45° field of view.
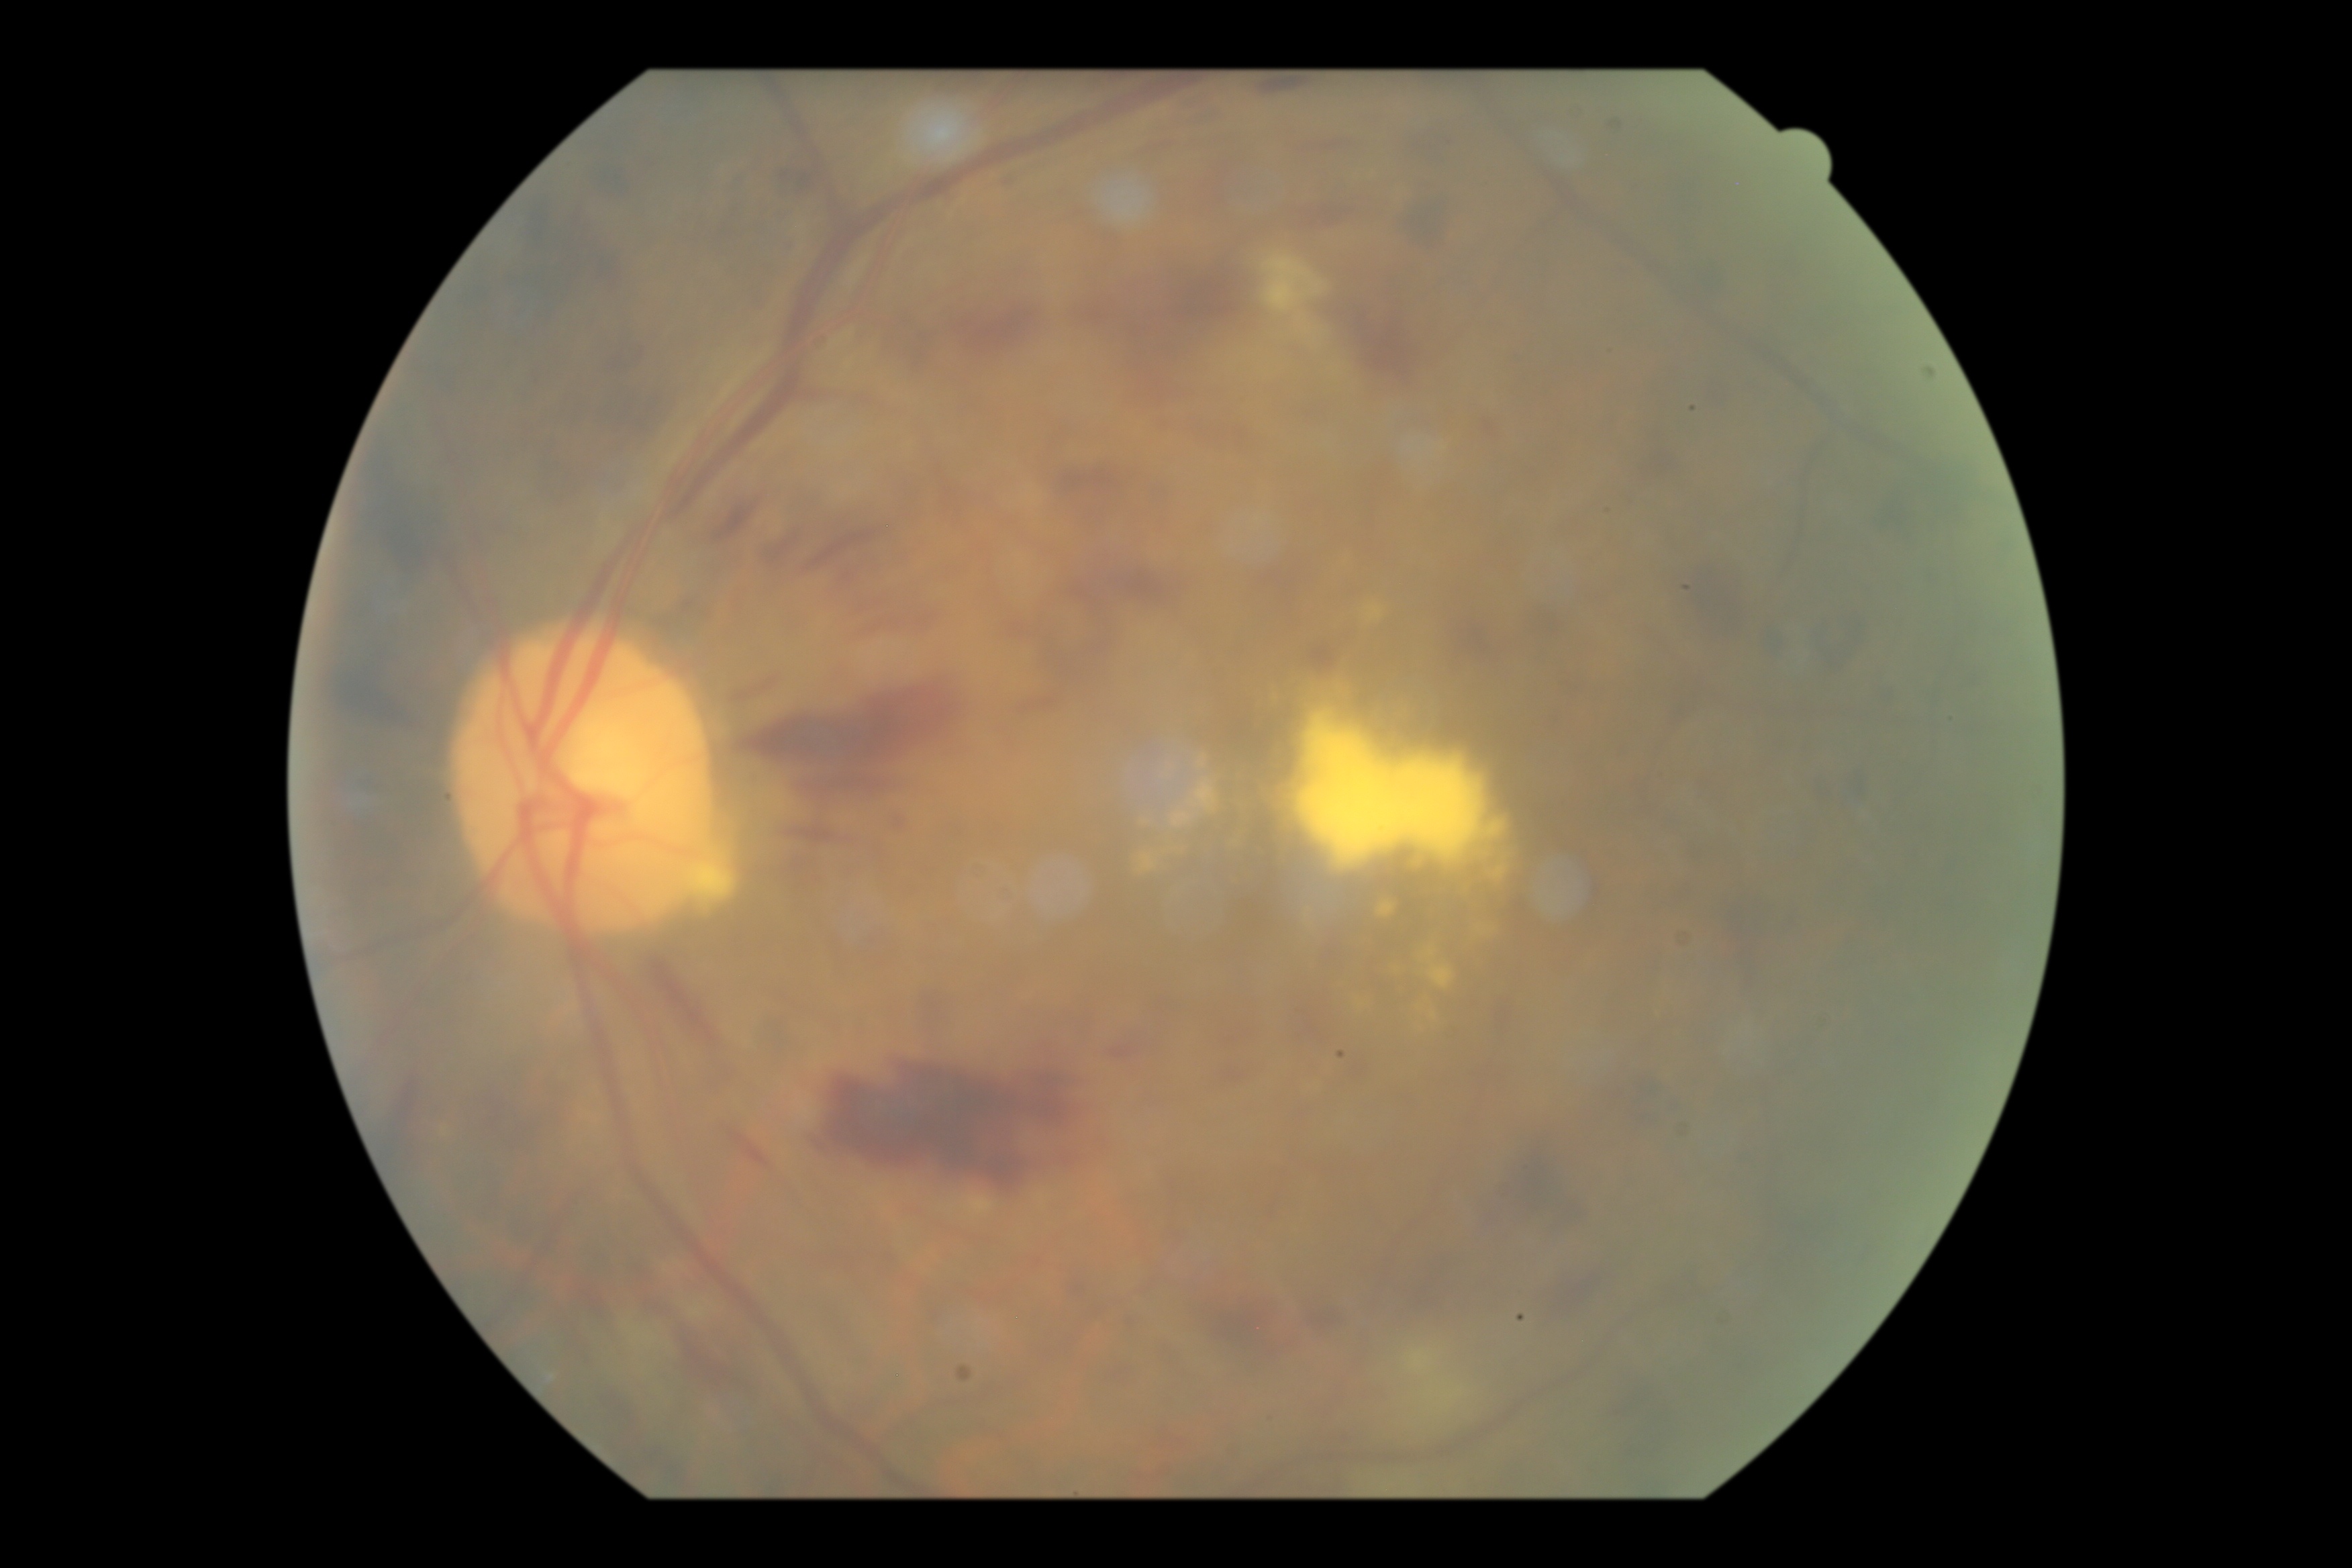 DR grade = 3/4.